848 by 848 pixels; acquired with a NIDEK AFC-230; nonmydriatic fundus photograph — 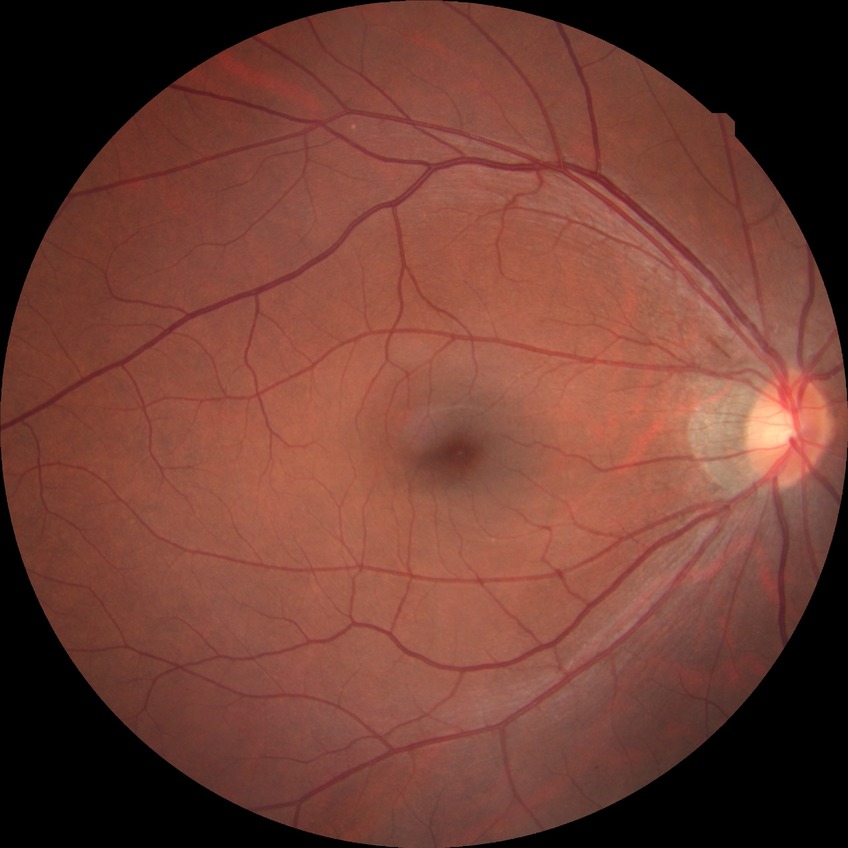

Assessment:
• diabetic retinopathy (DR) — no diabetic retinopathy (NDR)